Color fundus image.
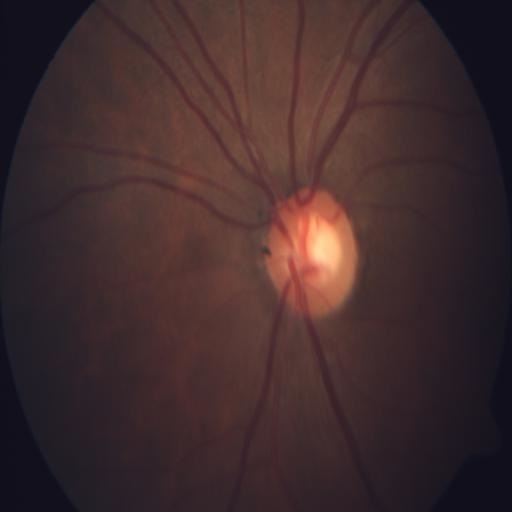
Showing optic disc cupping.